NIDEK AFC-230 fundus camera; color fundus photograph: 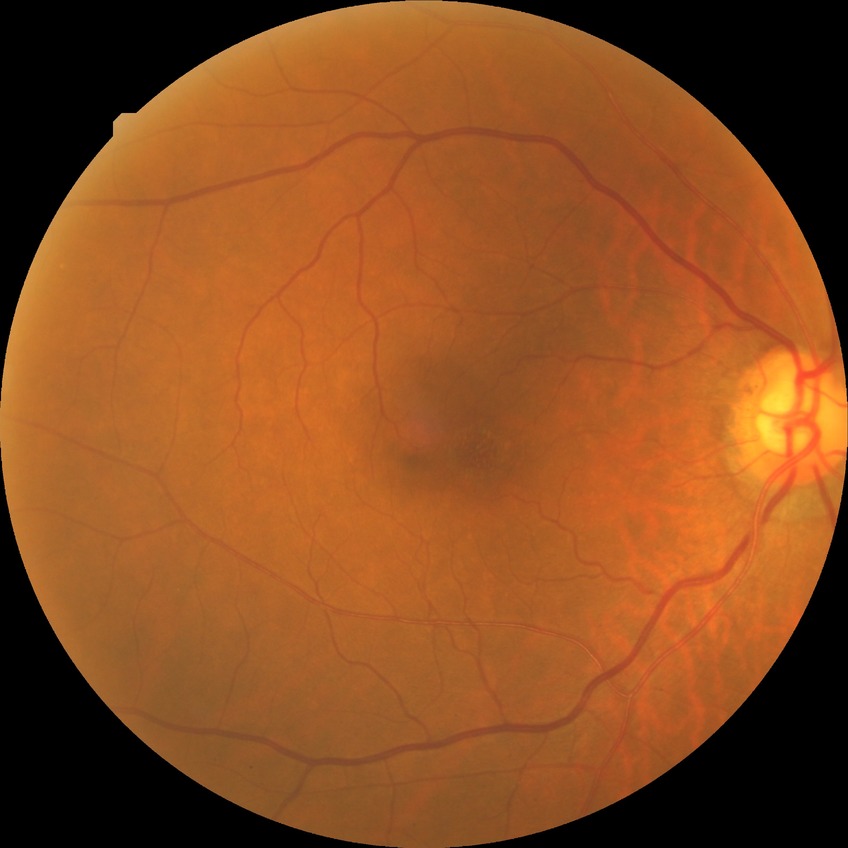
No DR findings. DR grade: NDR.